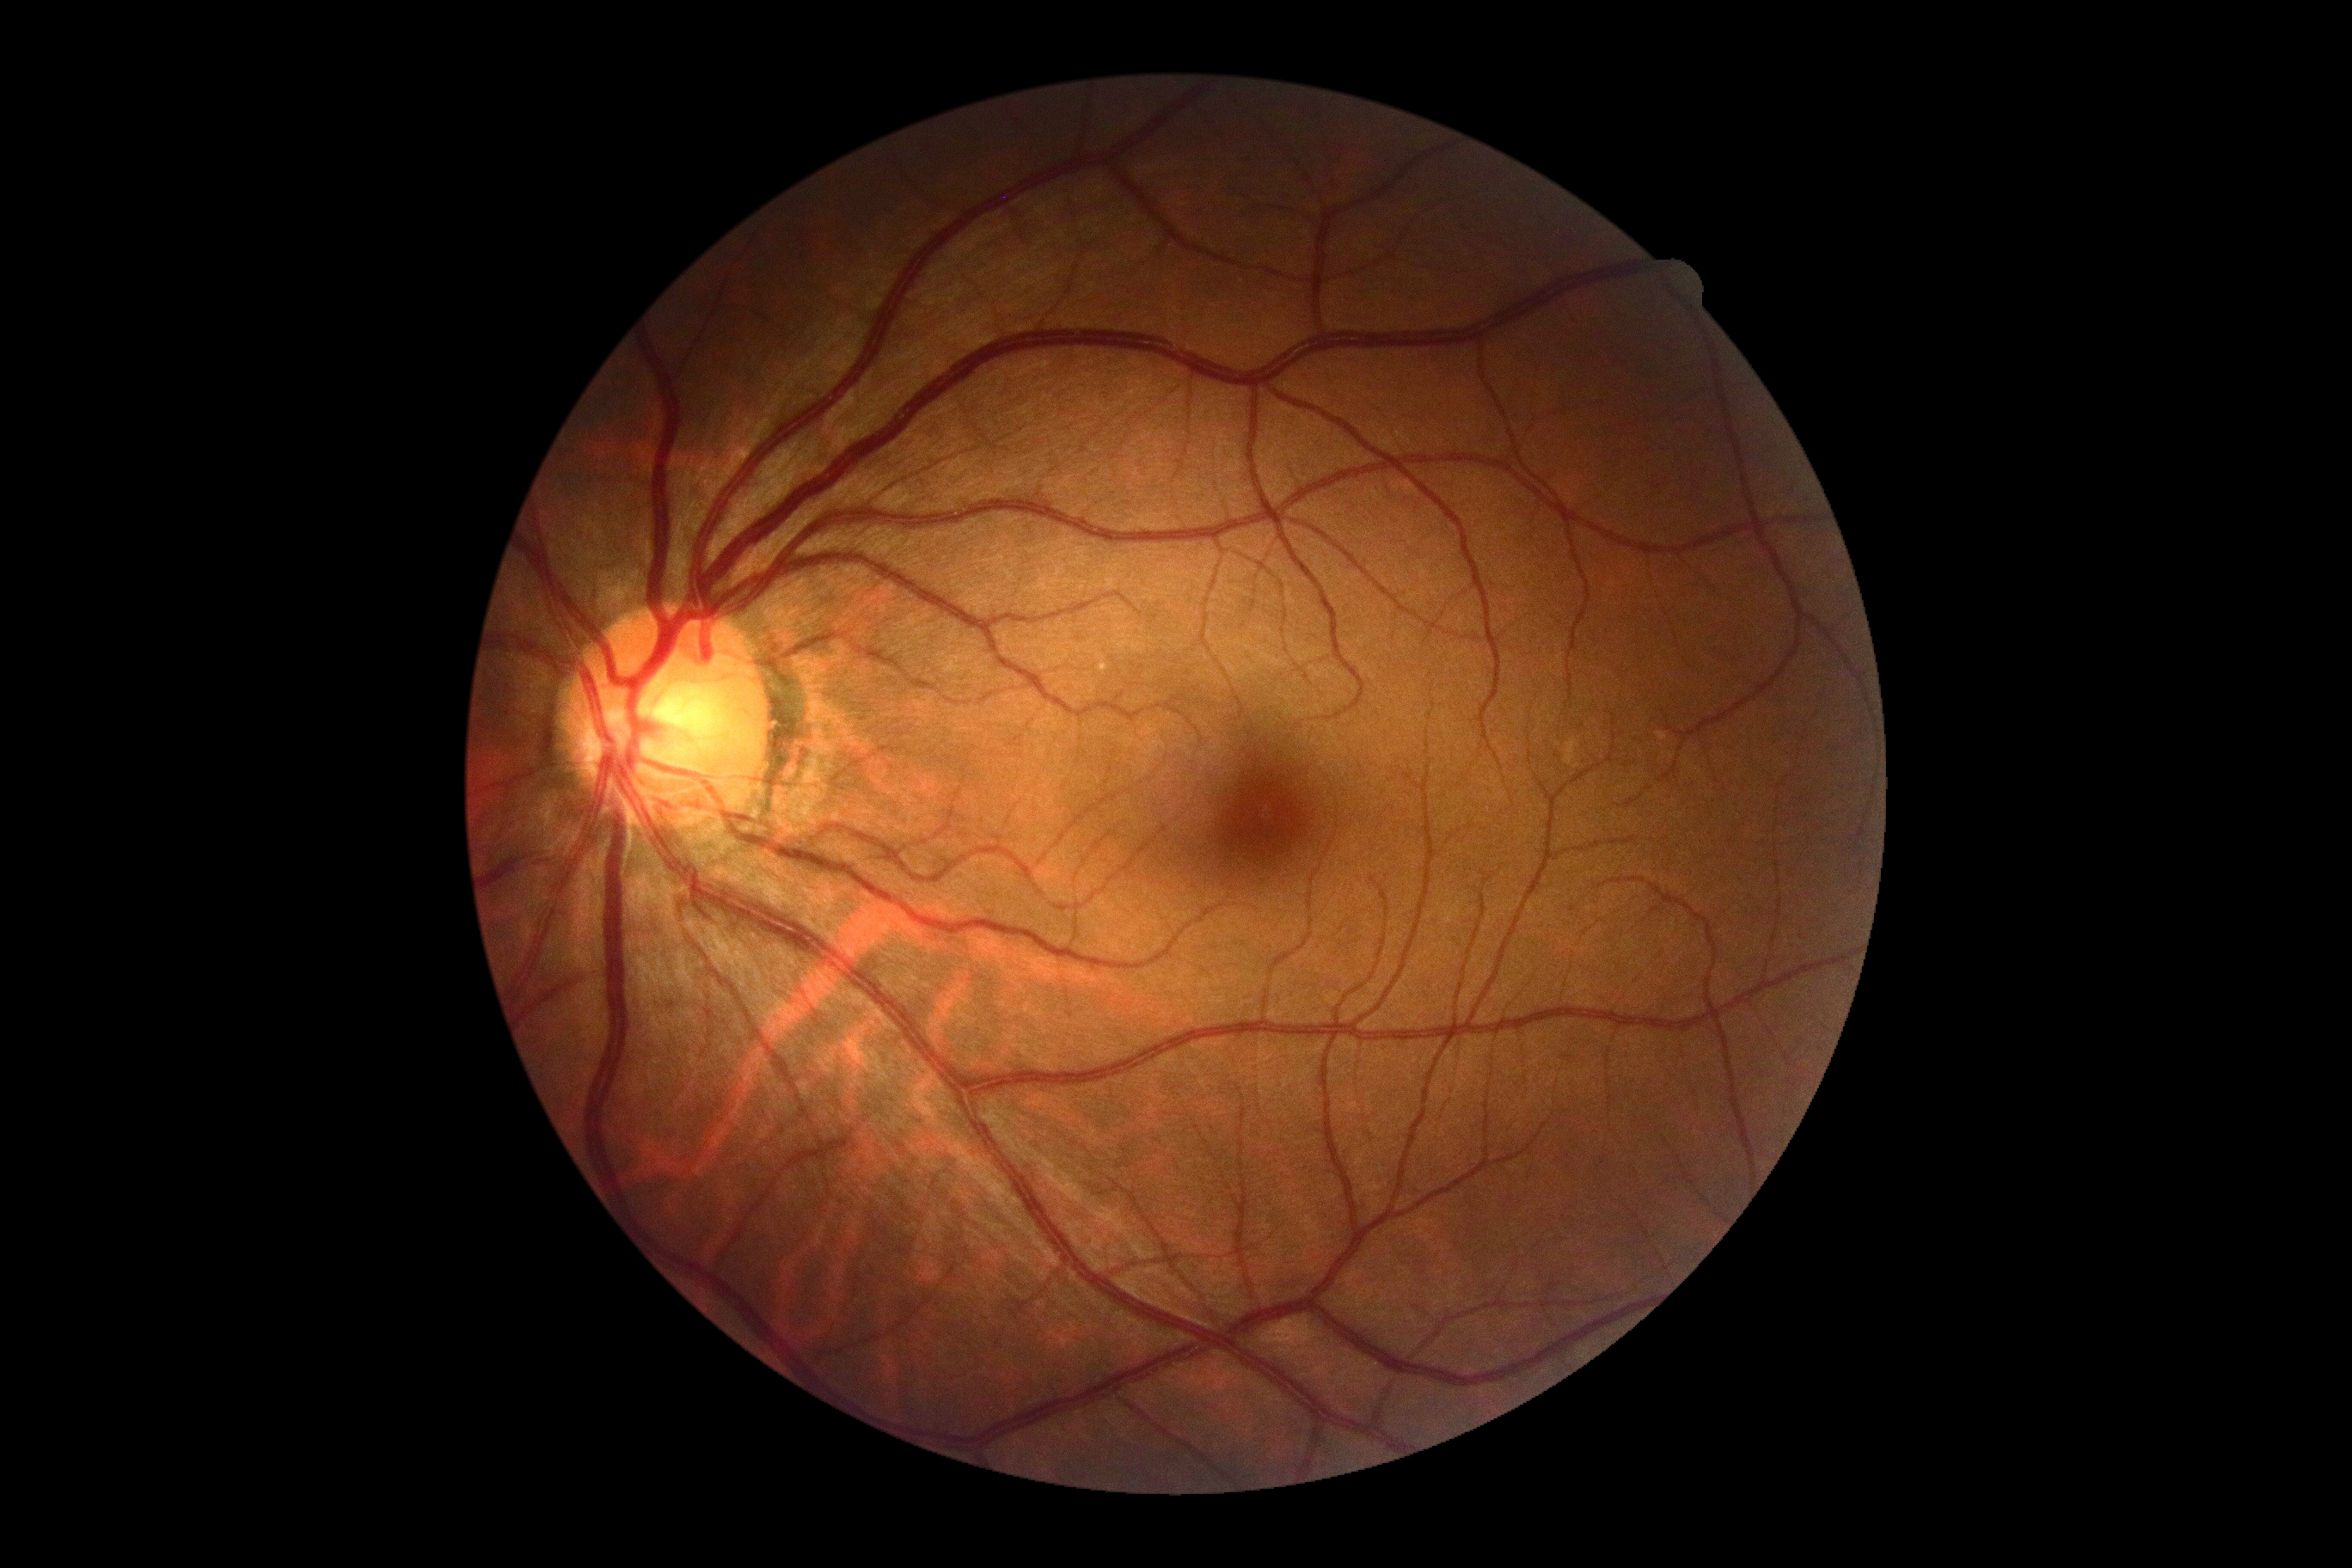

Diabetic retinopathy (DR): grade 0 (no apparent retinopathy).
No diabetic retinal disease findings.